FOV: 45 degrees
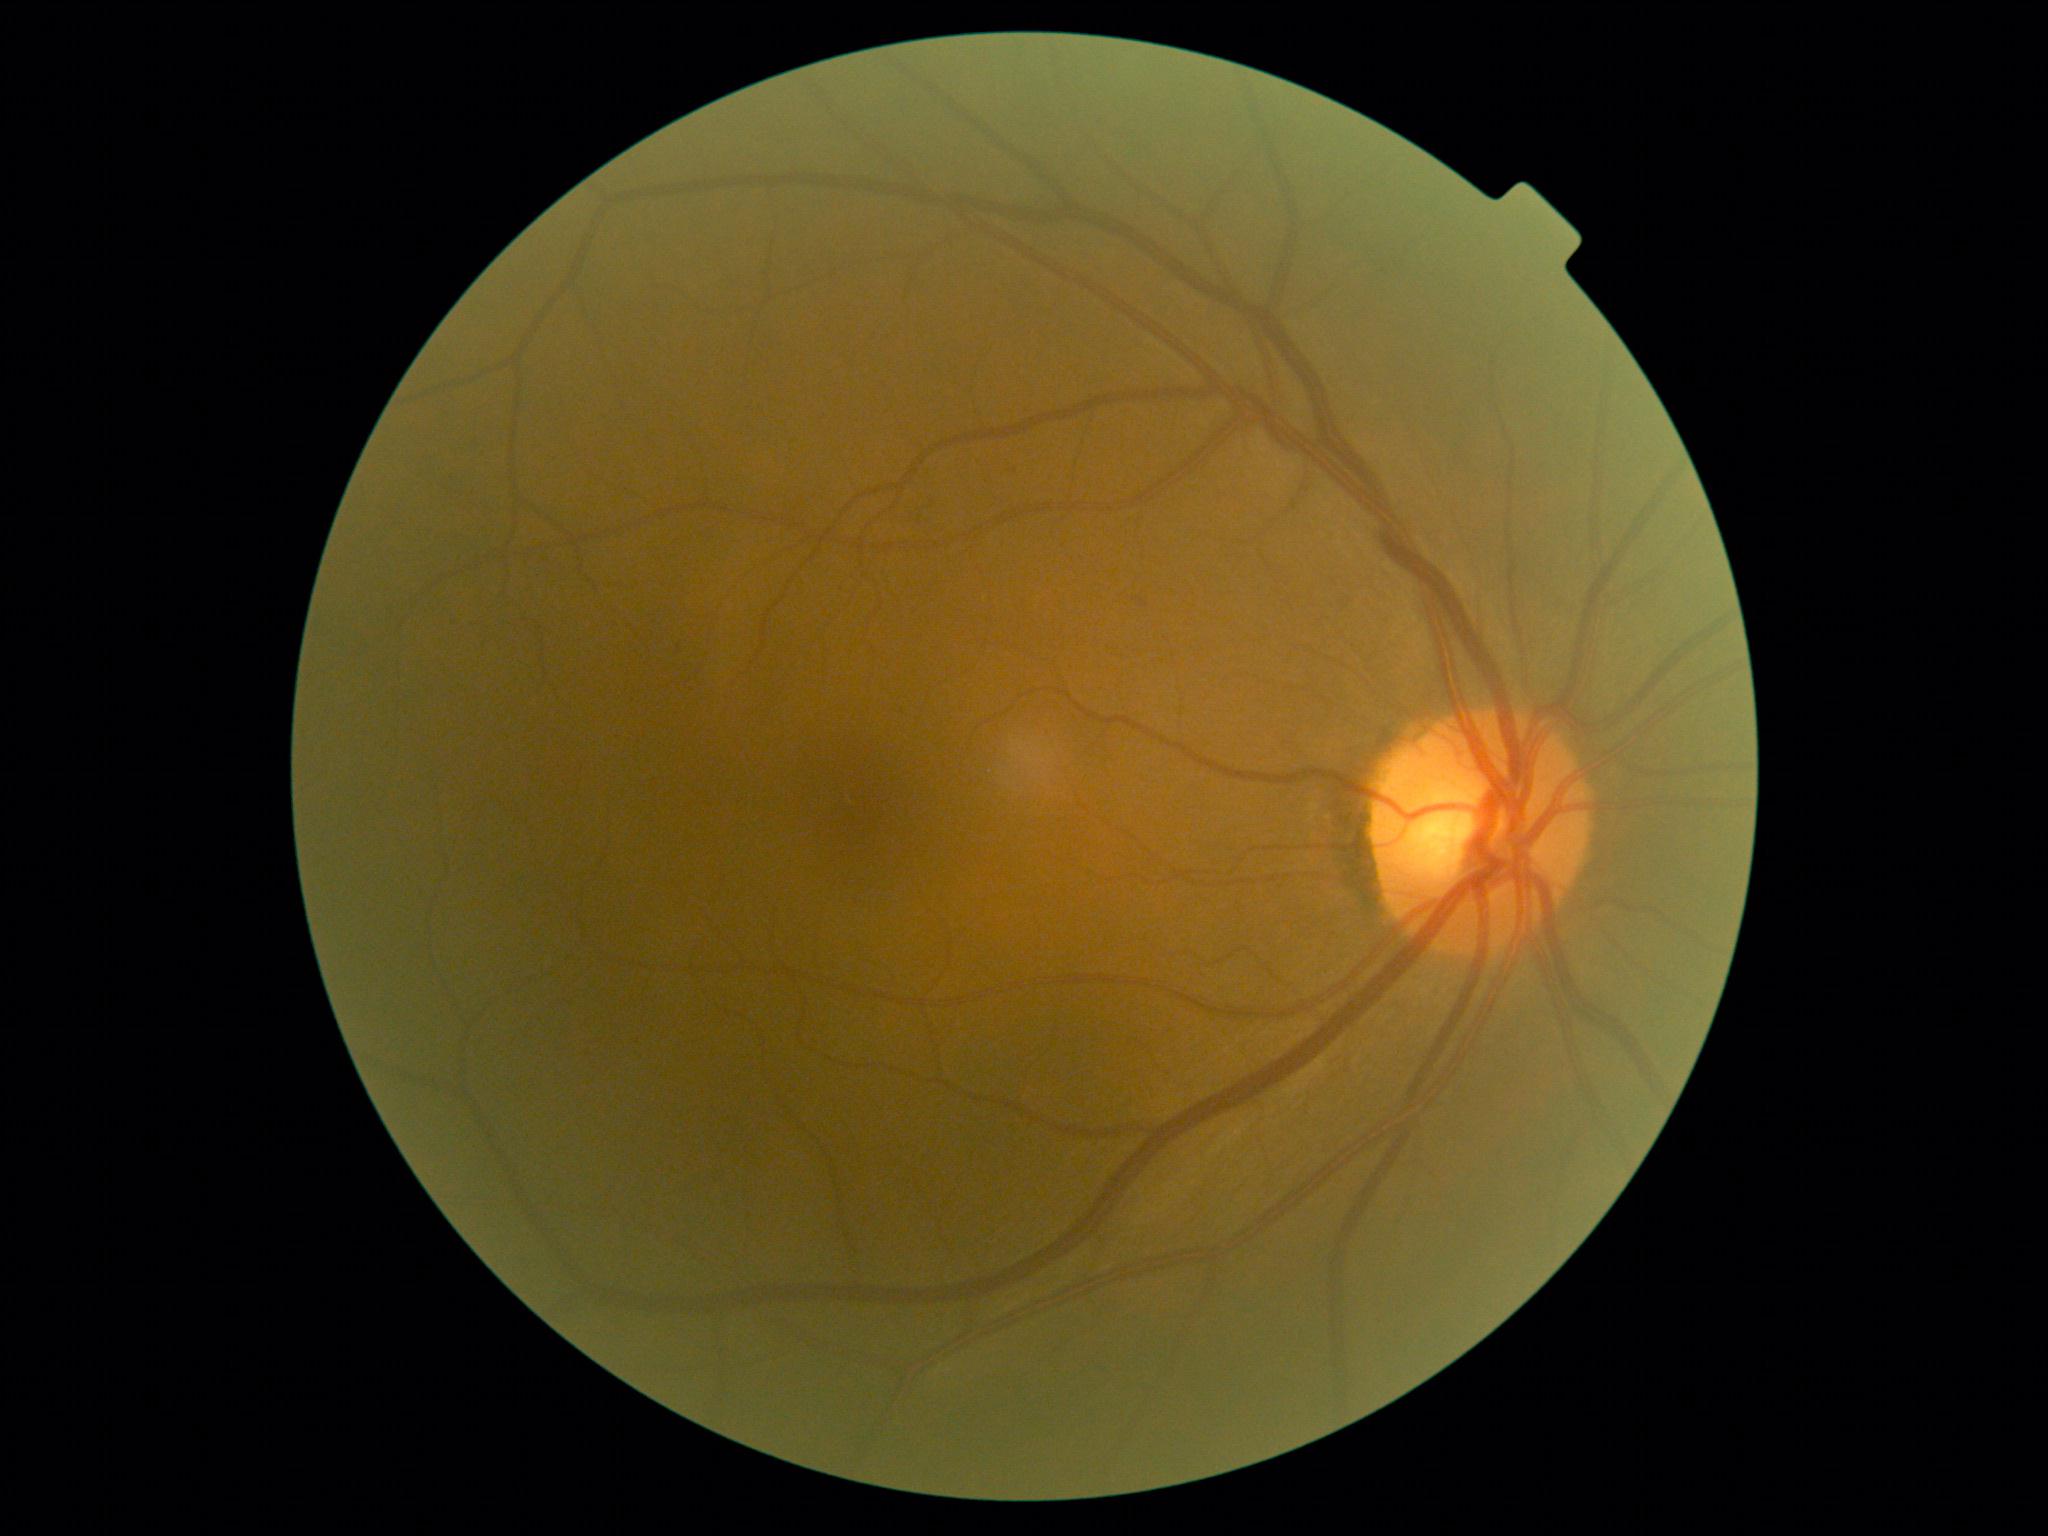 DR class: non-proliferative diabetic retinopathy. DR grade is 1 (mild NPDR).